Camera: Phoenix ICON (100° FOV) · wide-field contact fundus photograph of an infant.
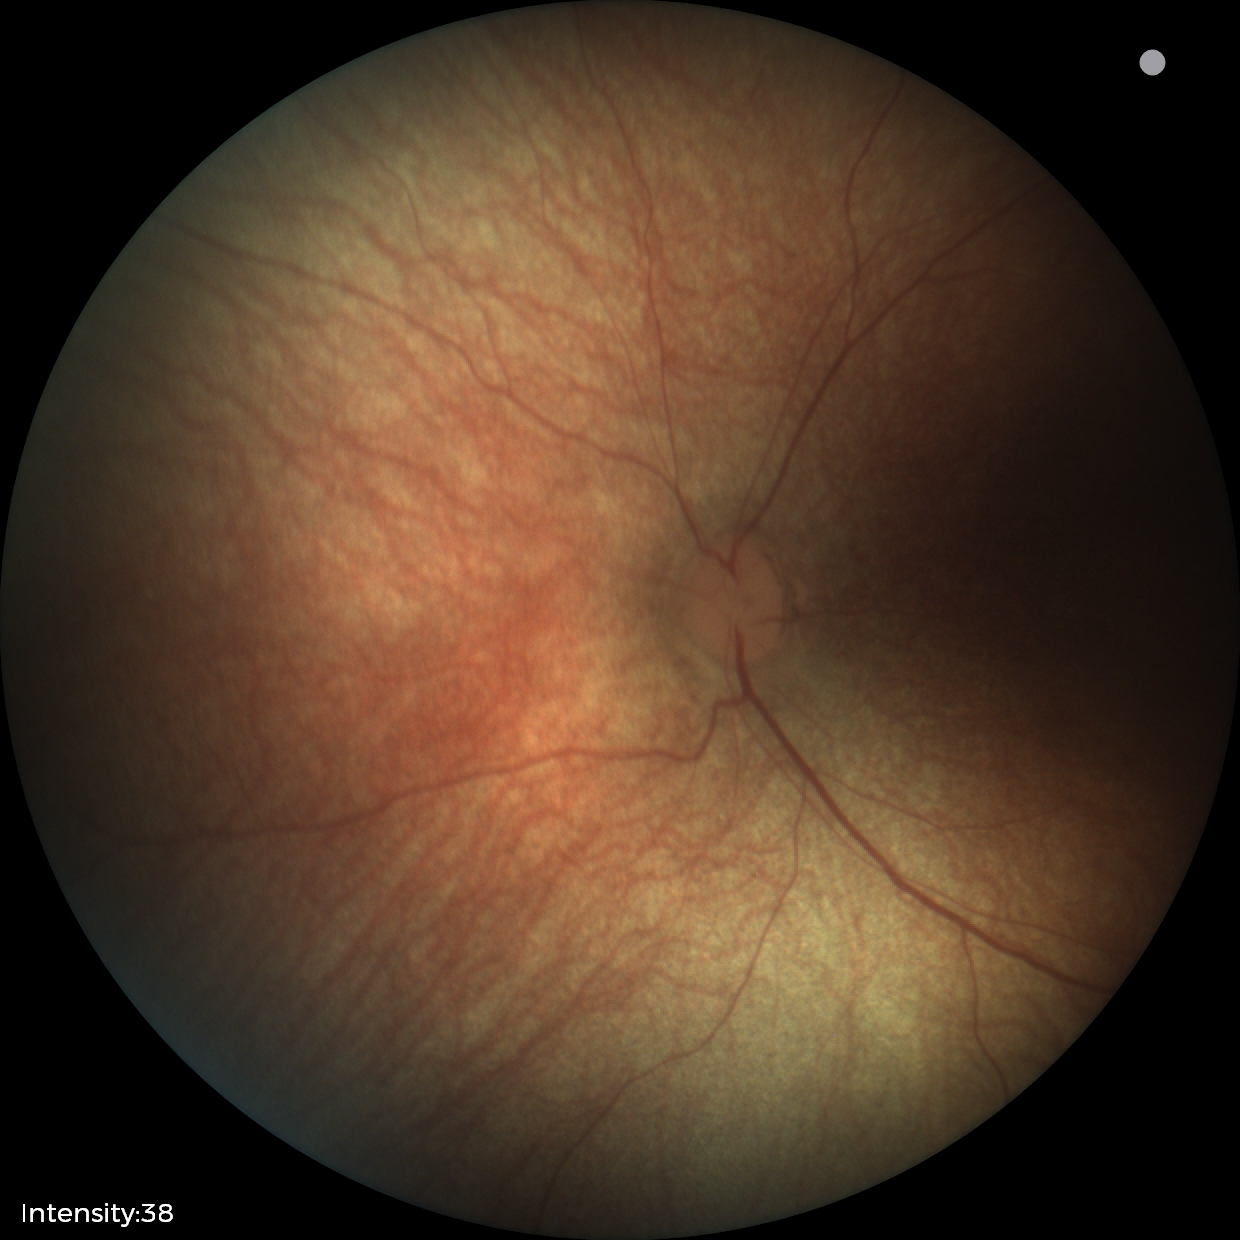 Normal screening examination.